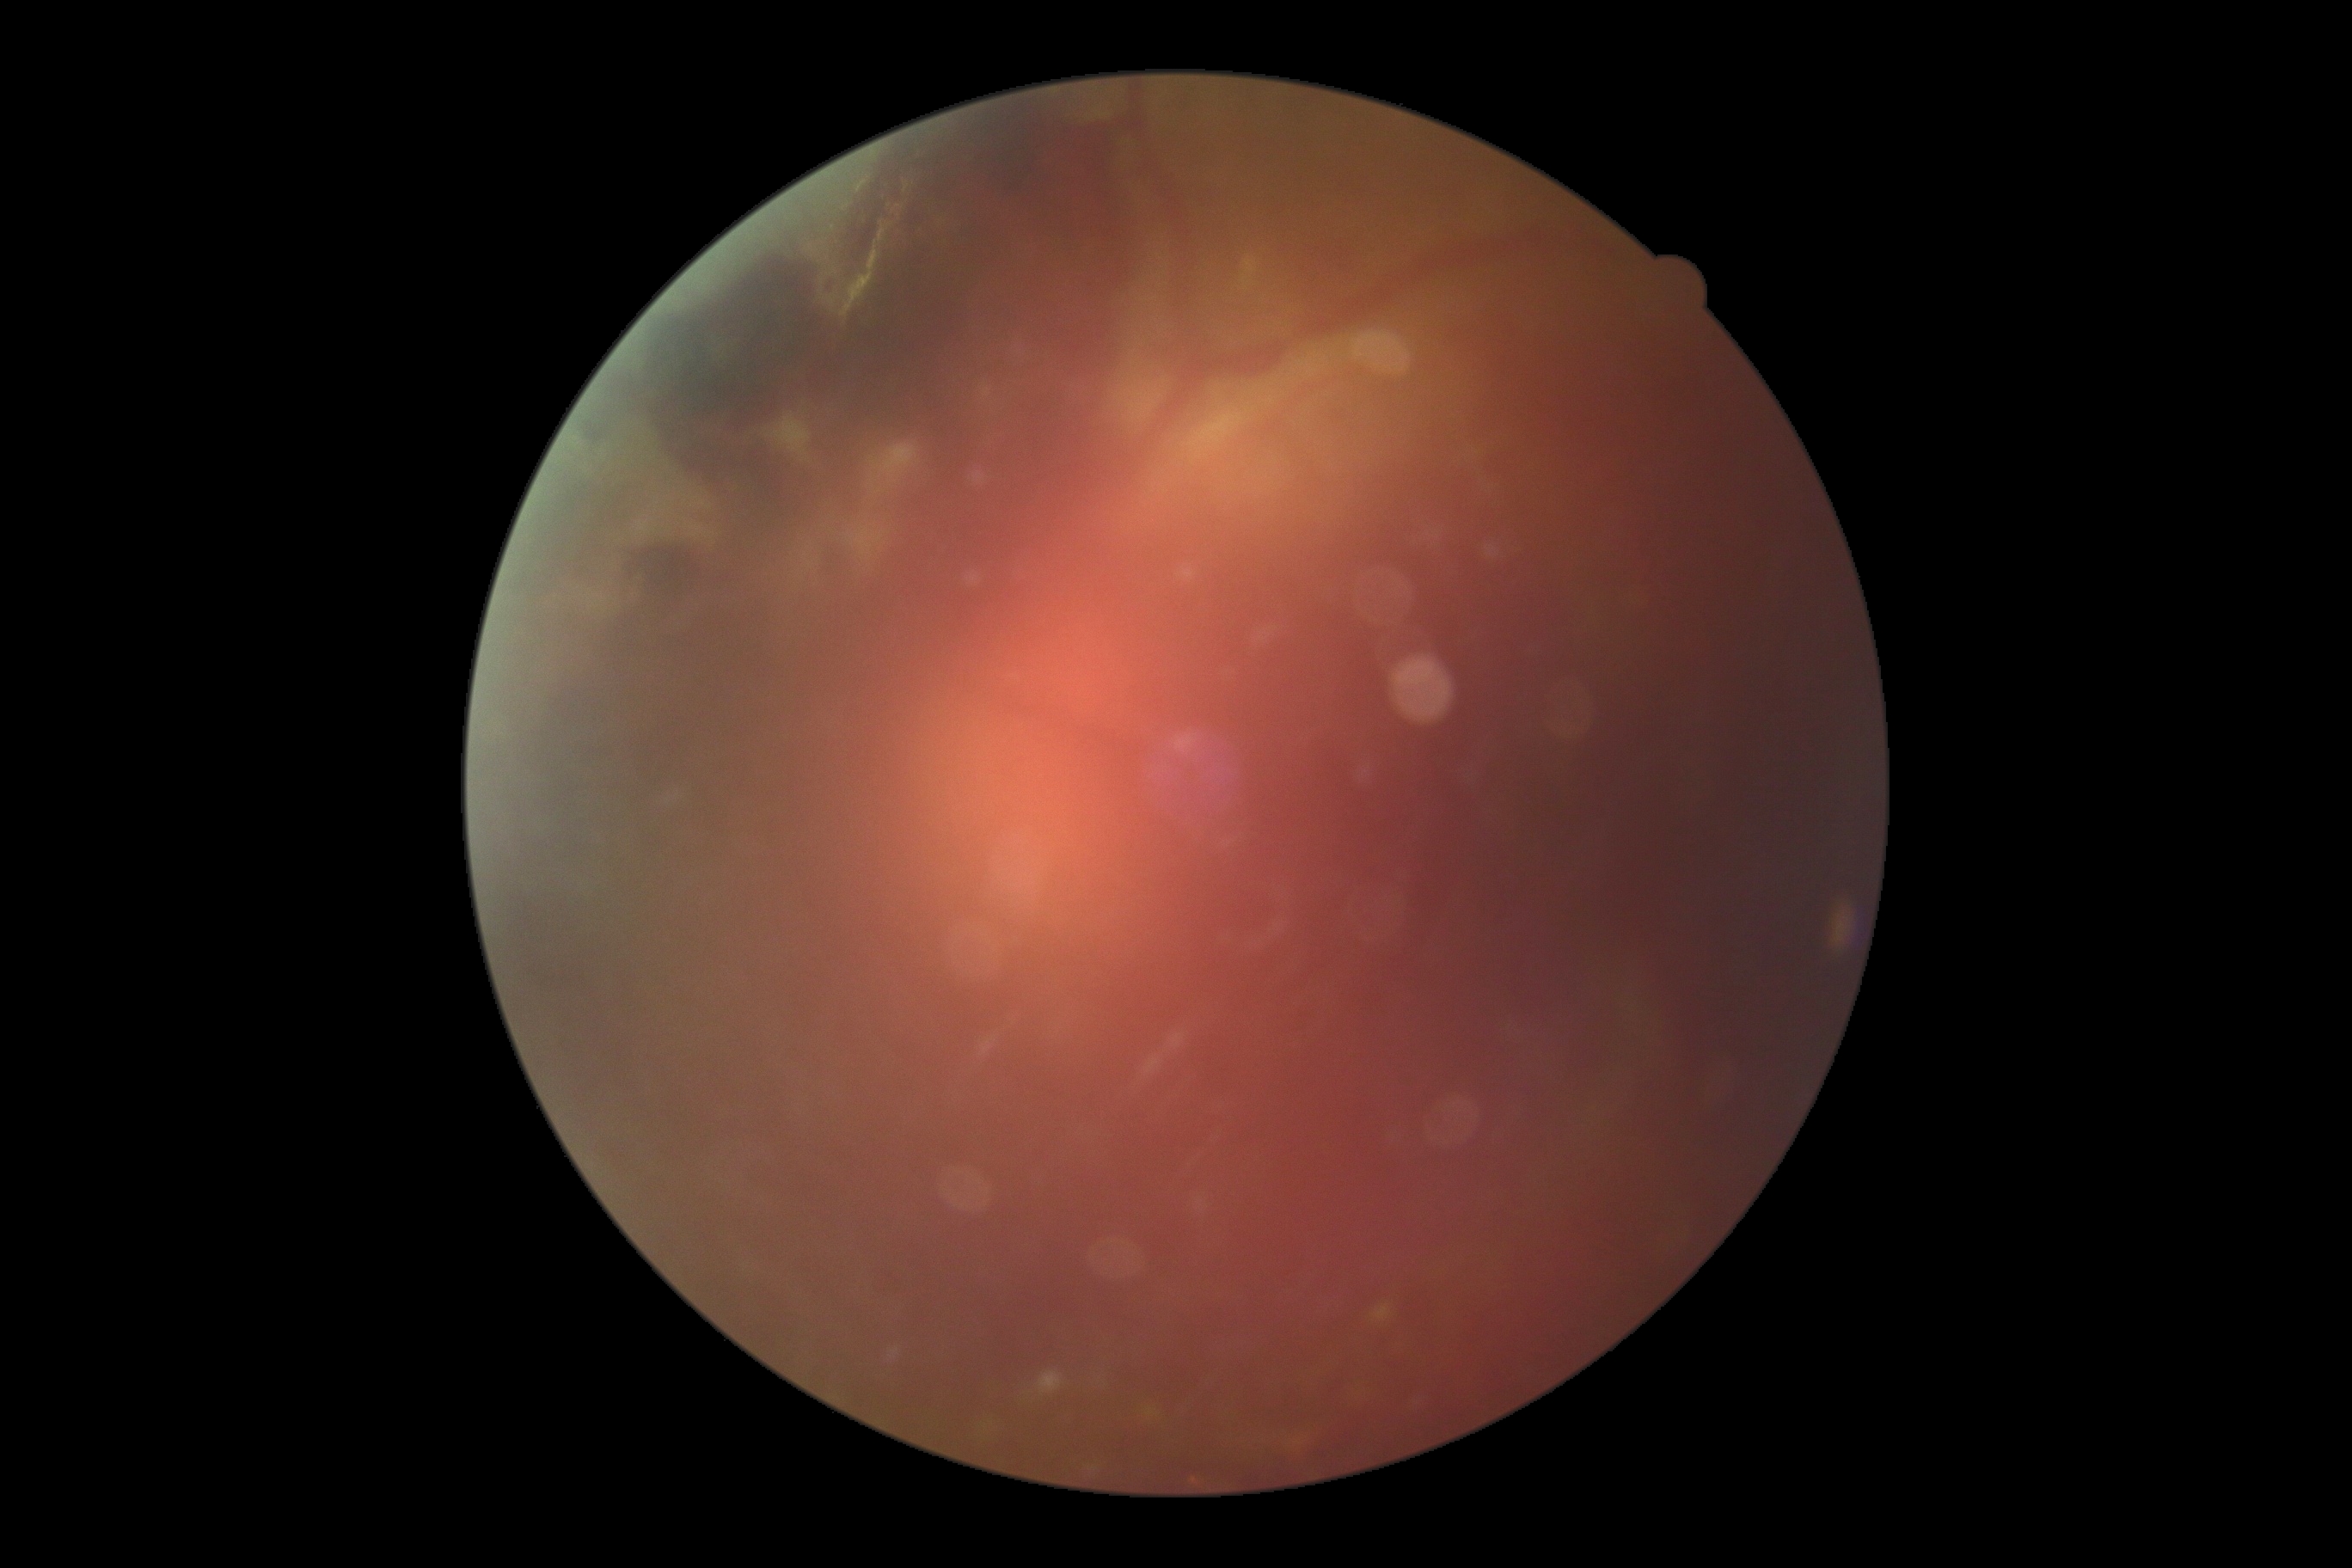 Retinopathy grade: 4.